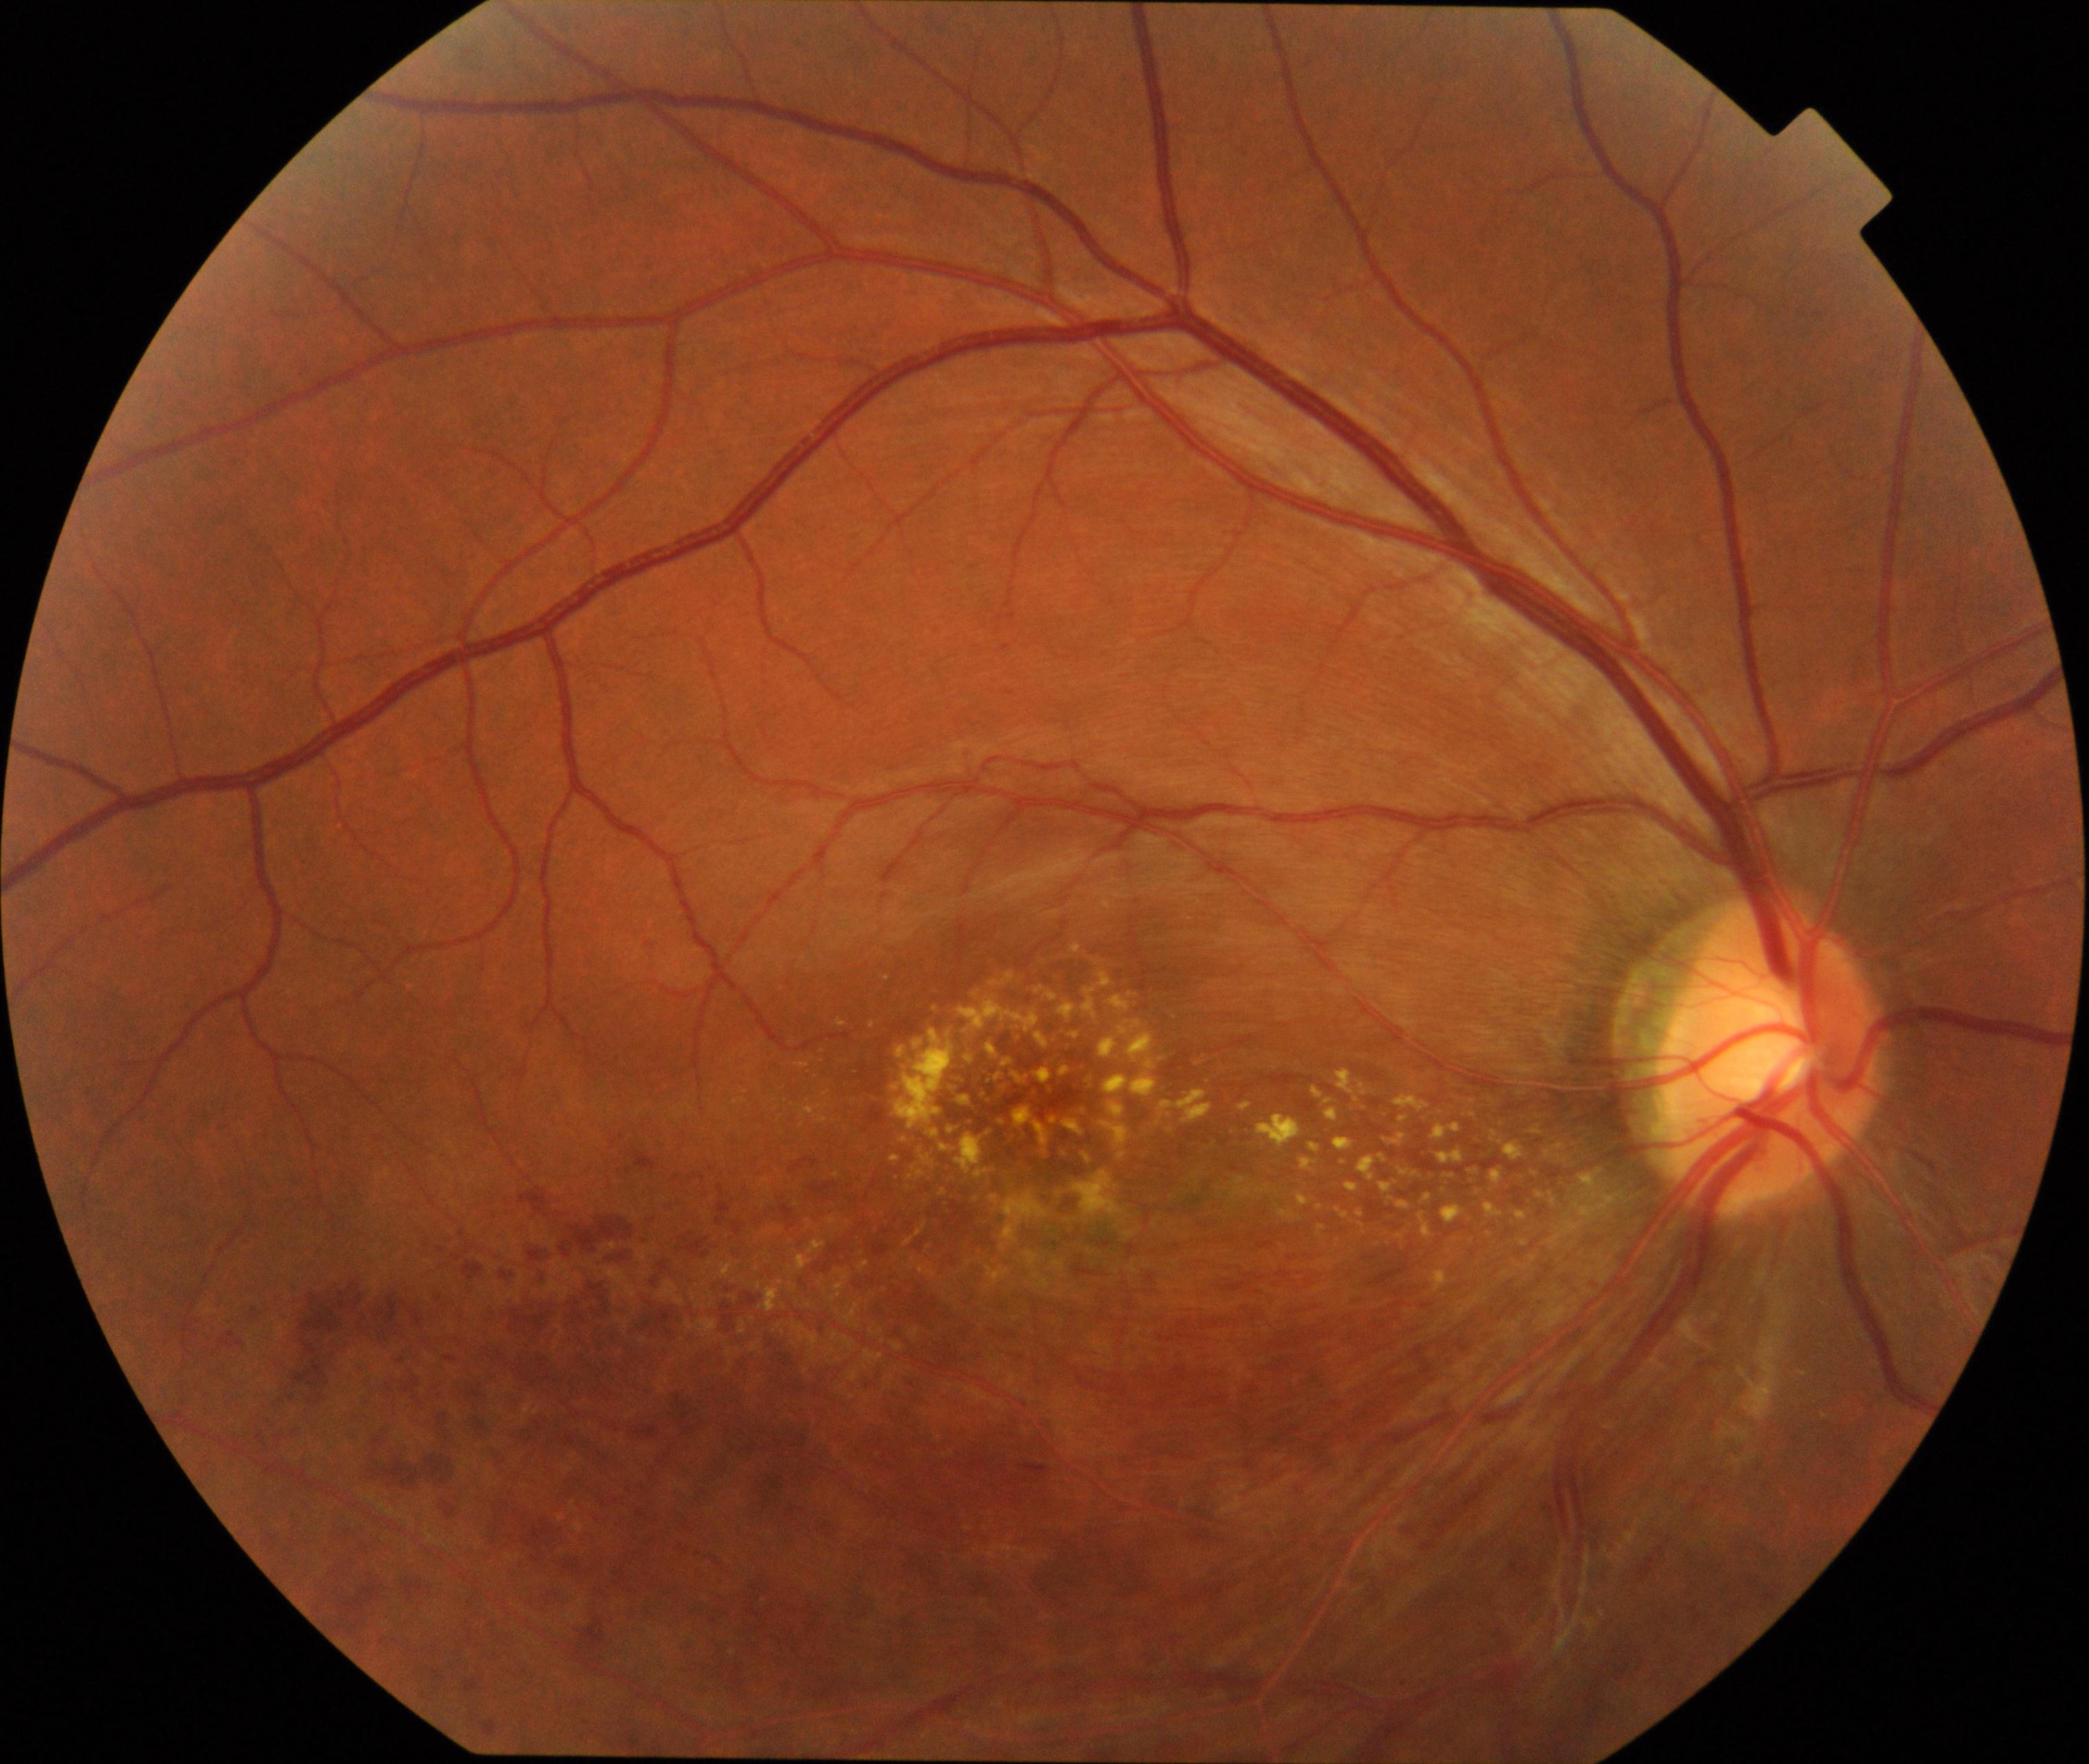
Primary finding: branch retinal vein occlusion (BRVO).